45° FOV · nonmydriatic: 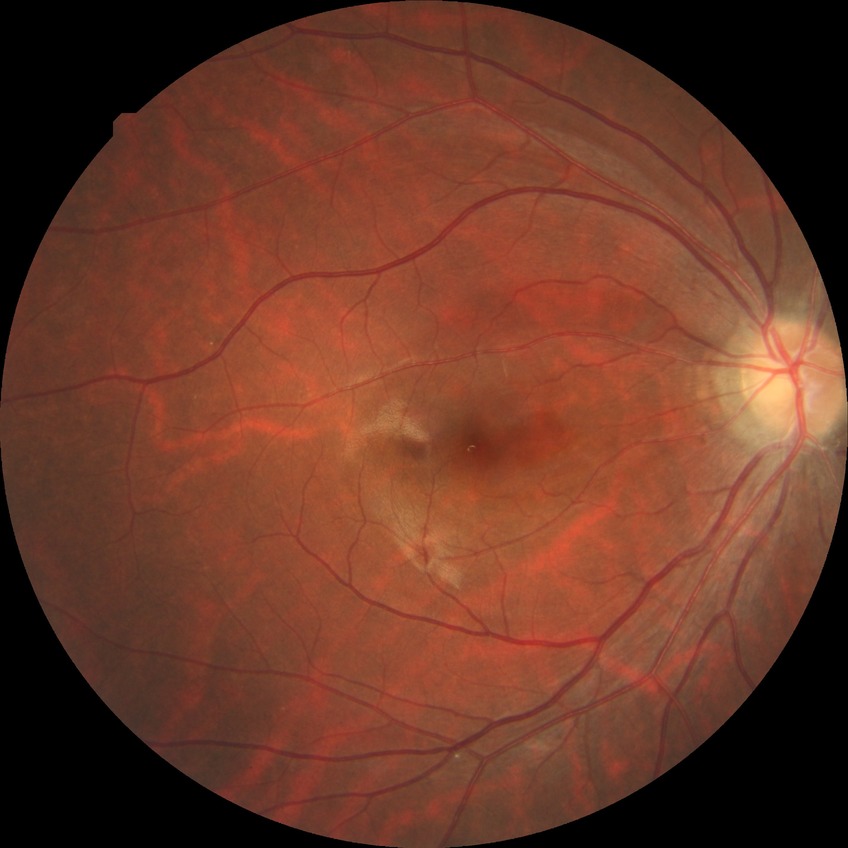 No DR findings.
DR severity is NDR.